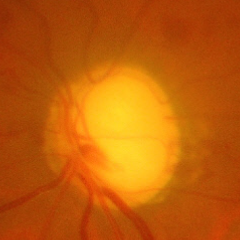

Glaucoma assessment = advanced-stage glaucoma.